Color fundus image.
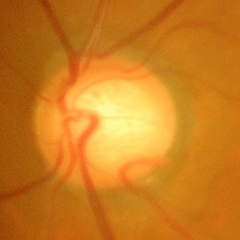

Glaucomatous optic neuropathy is present. Findings consistent with severe glaucomatous damage.